Color fundus photograph; acquired with a Remidio FOP fundus camera — 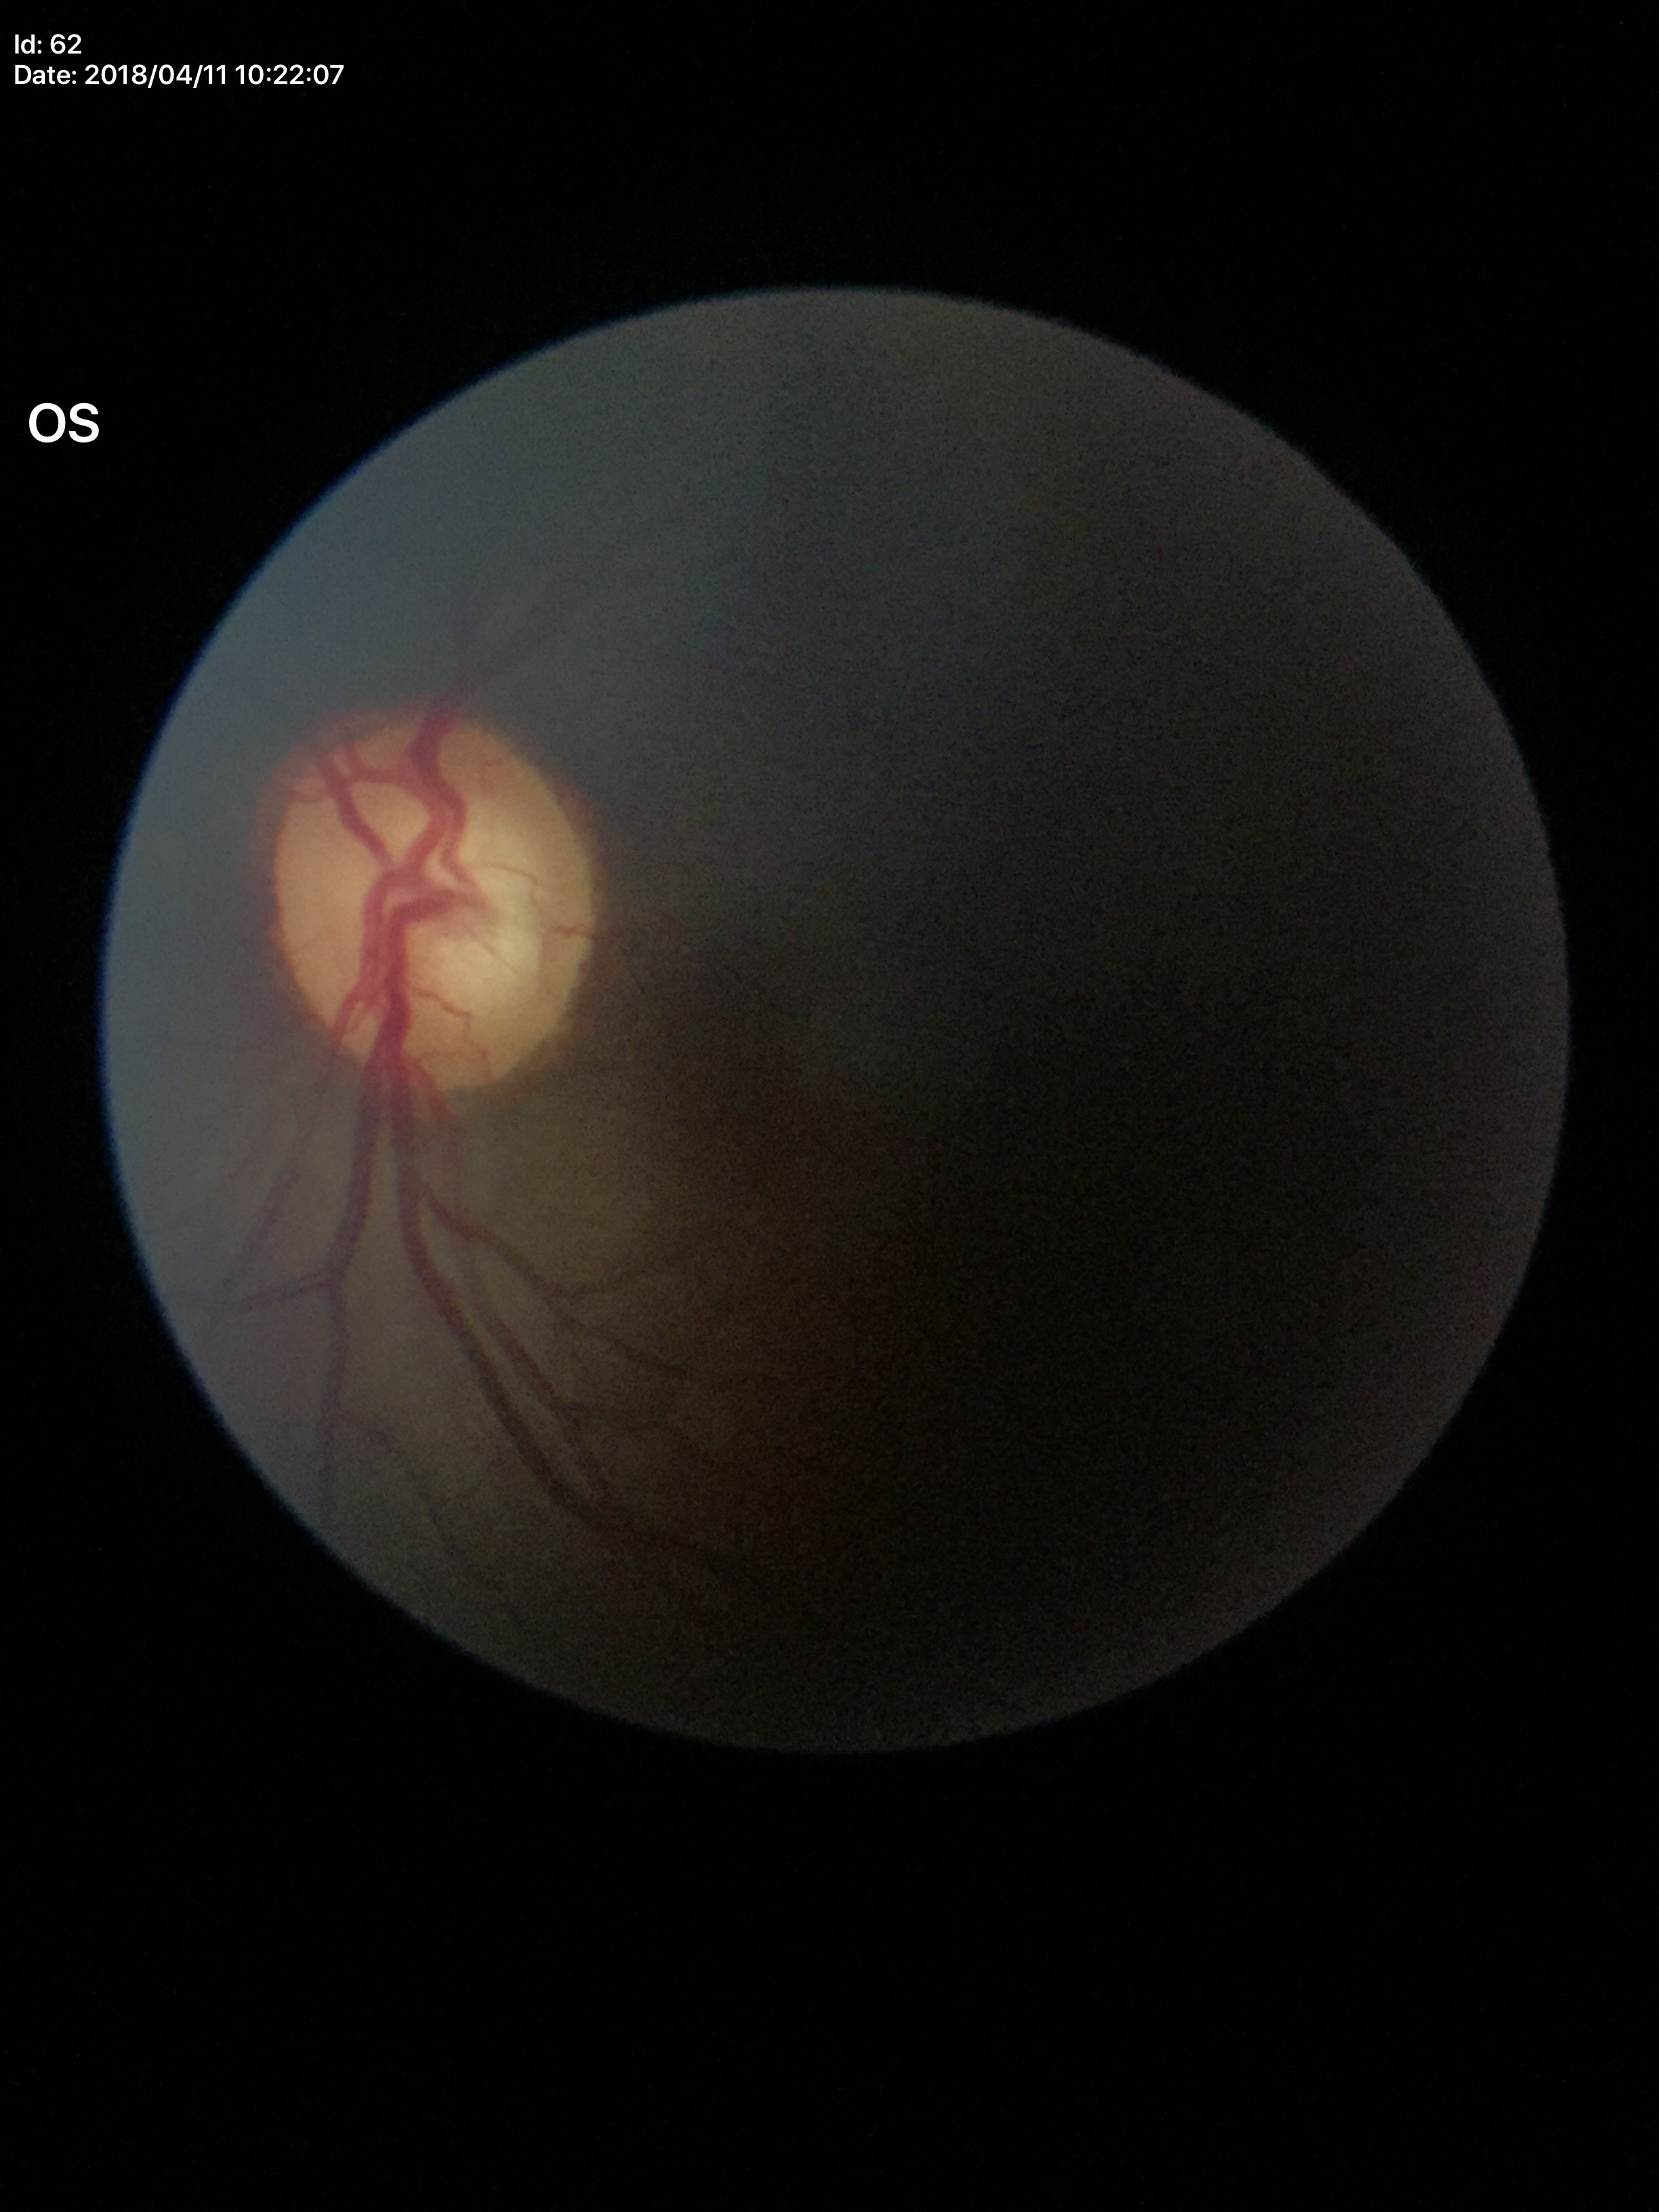

Glaucoma assessment: suspect. VCDR: 0.71. HCDR is 0.64. ACDR: 0.45.